Color fundus photograph — 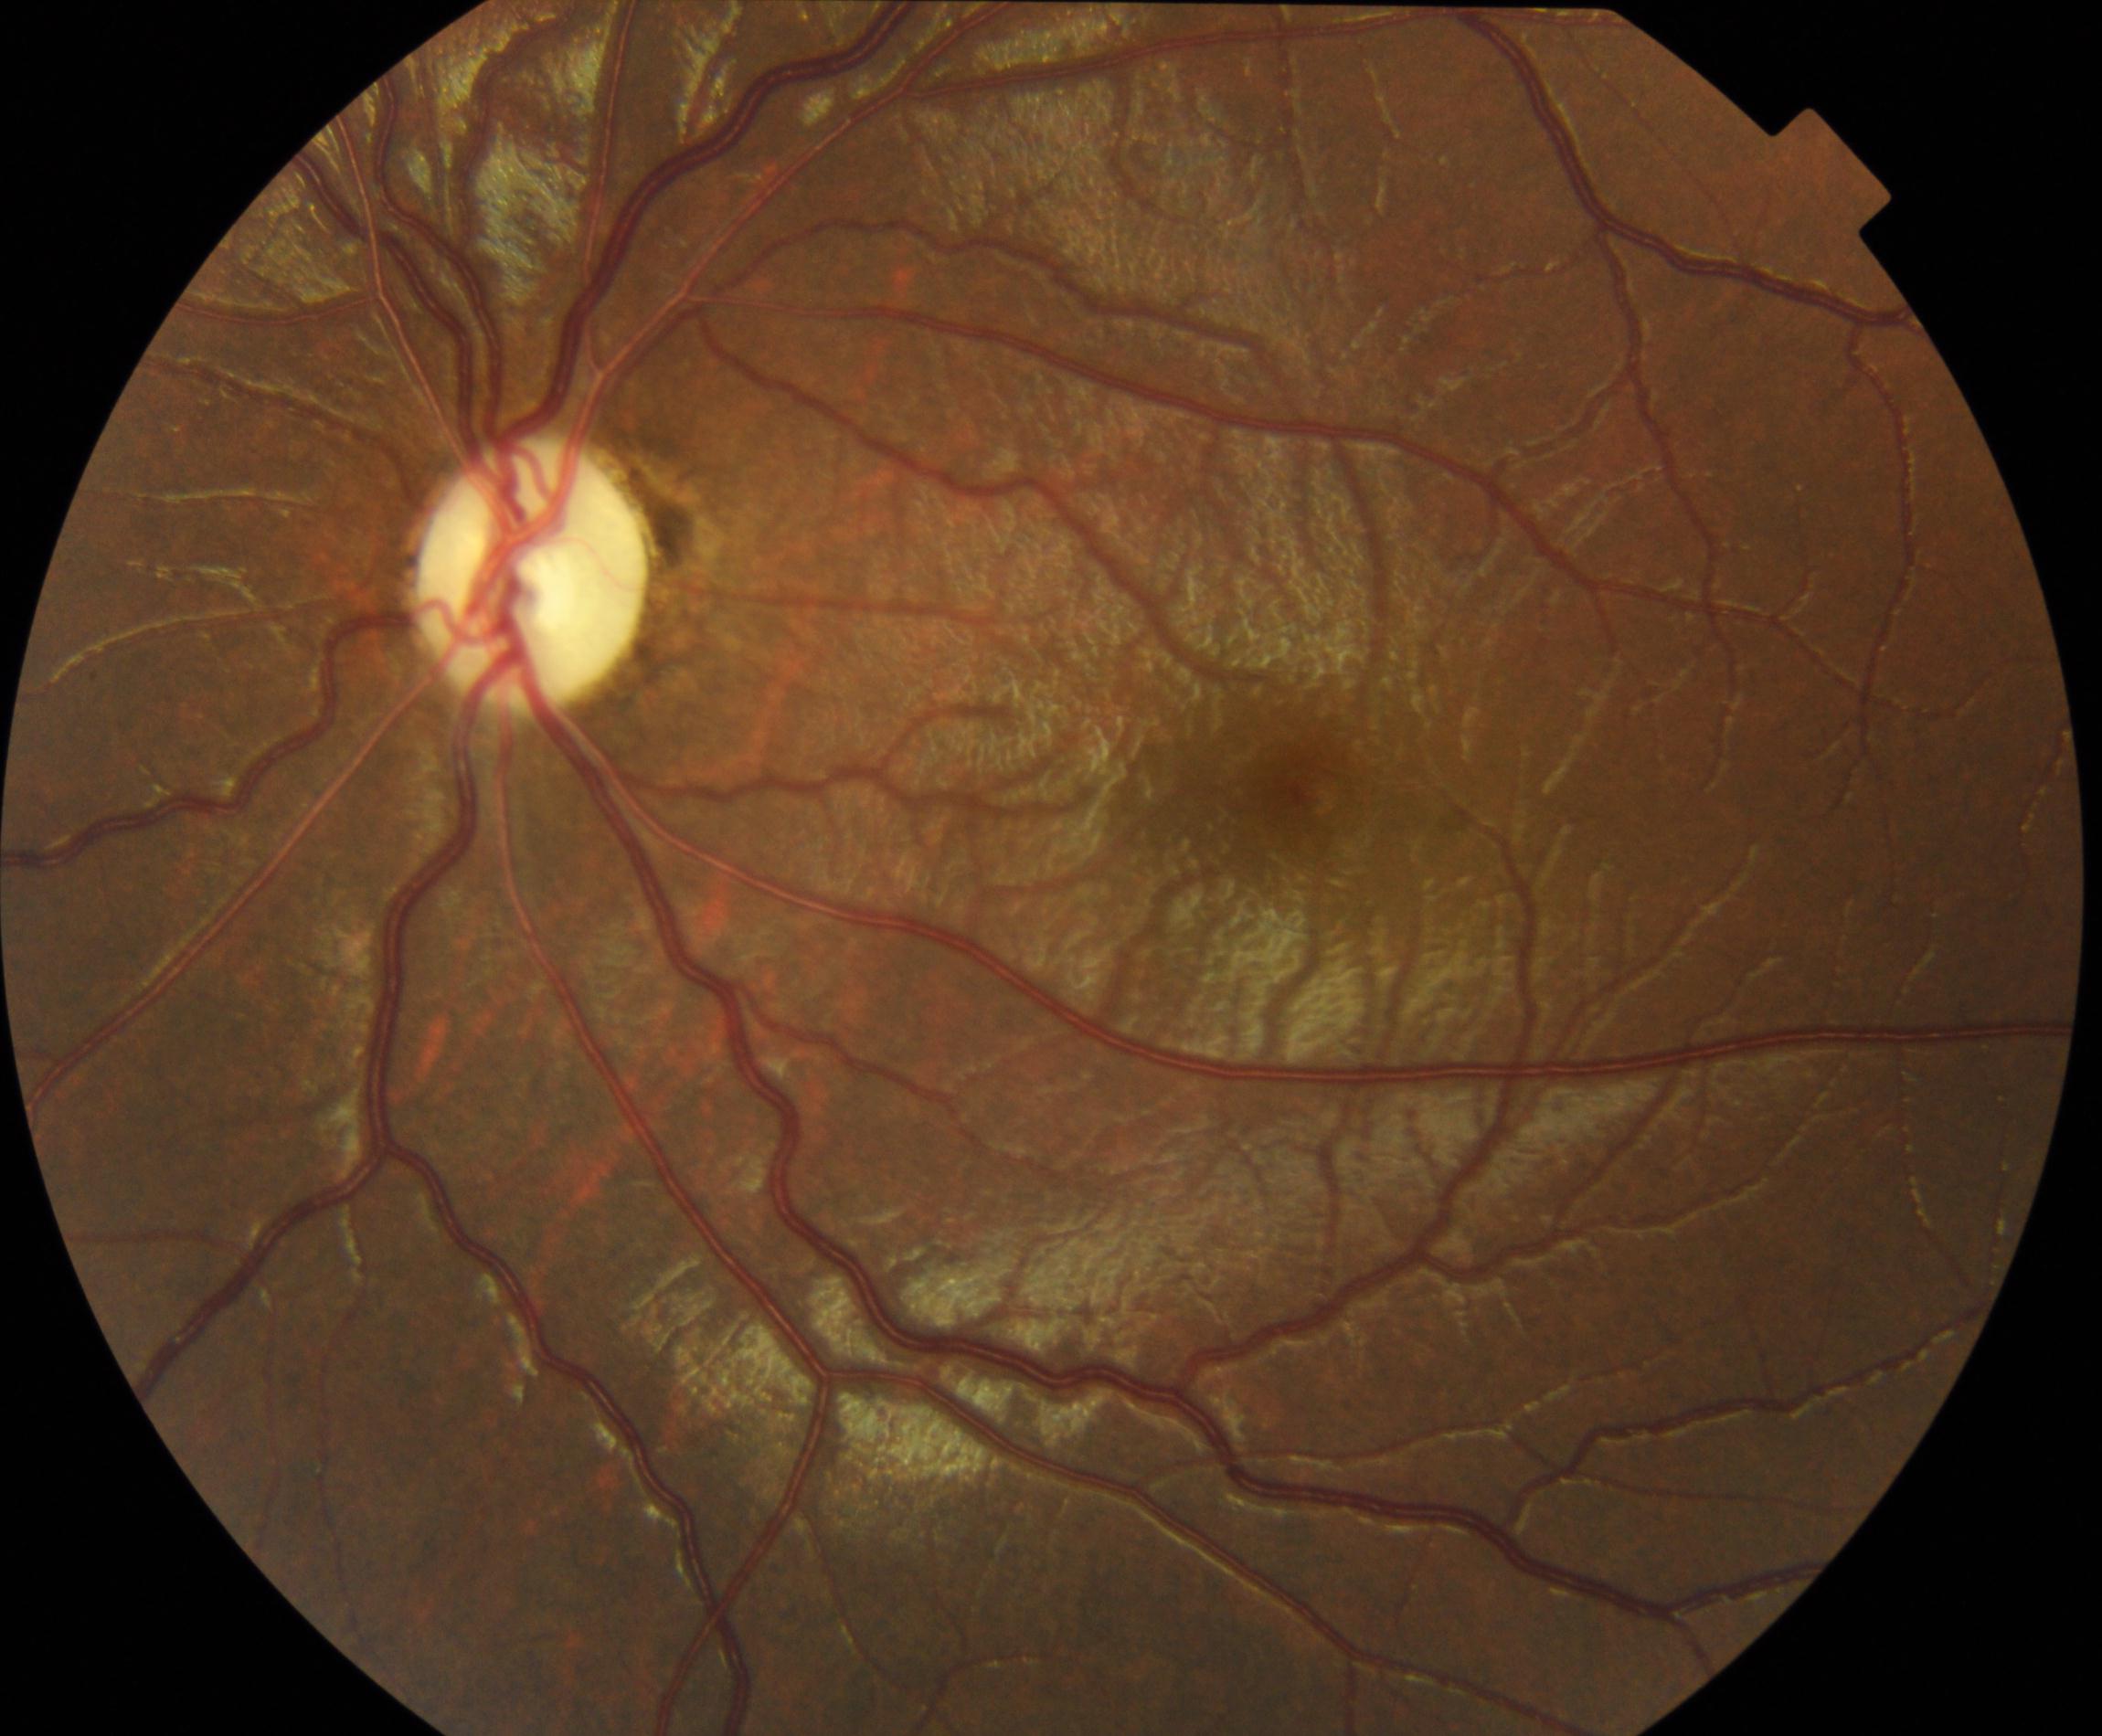 Findings: optic atrophy.